Posterior pole color fundus photograph; DR severity per modified Davis staging.
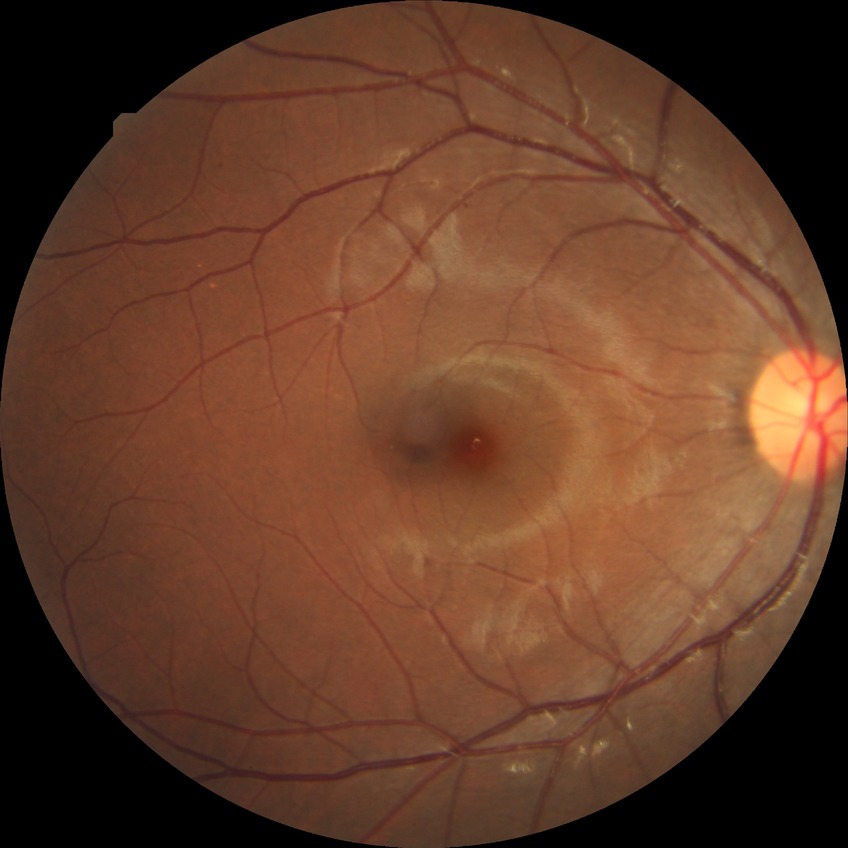
diabetic retinopathy (DR) = SDR (simple diabetic retinopathy)